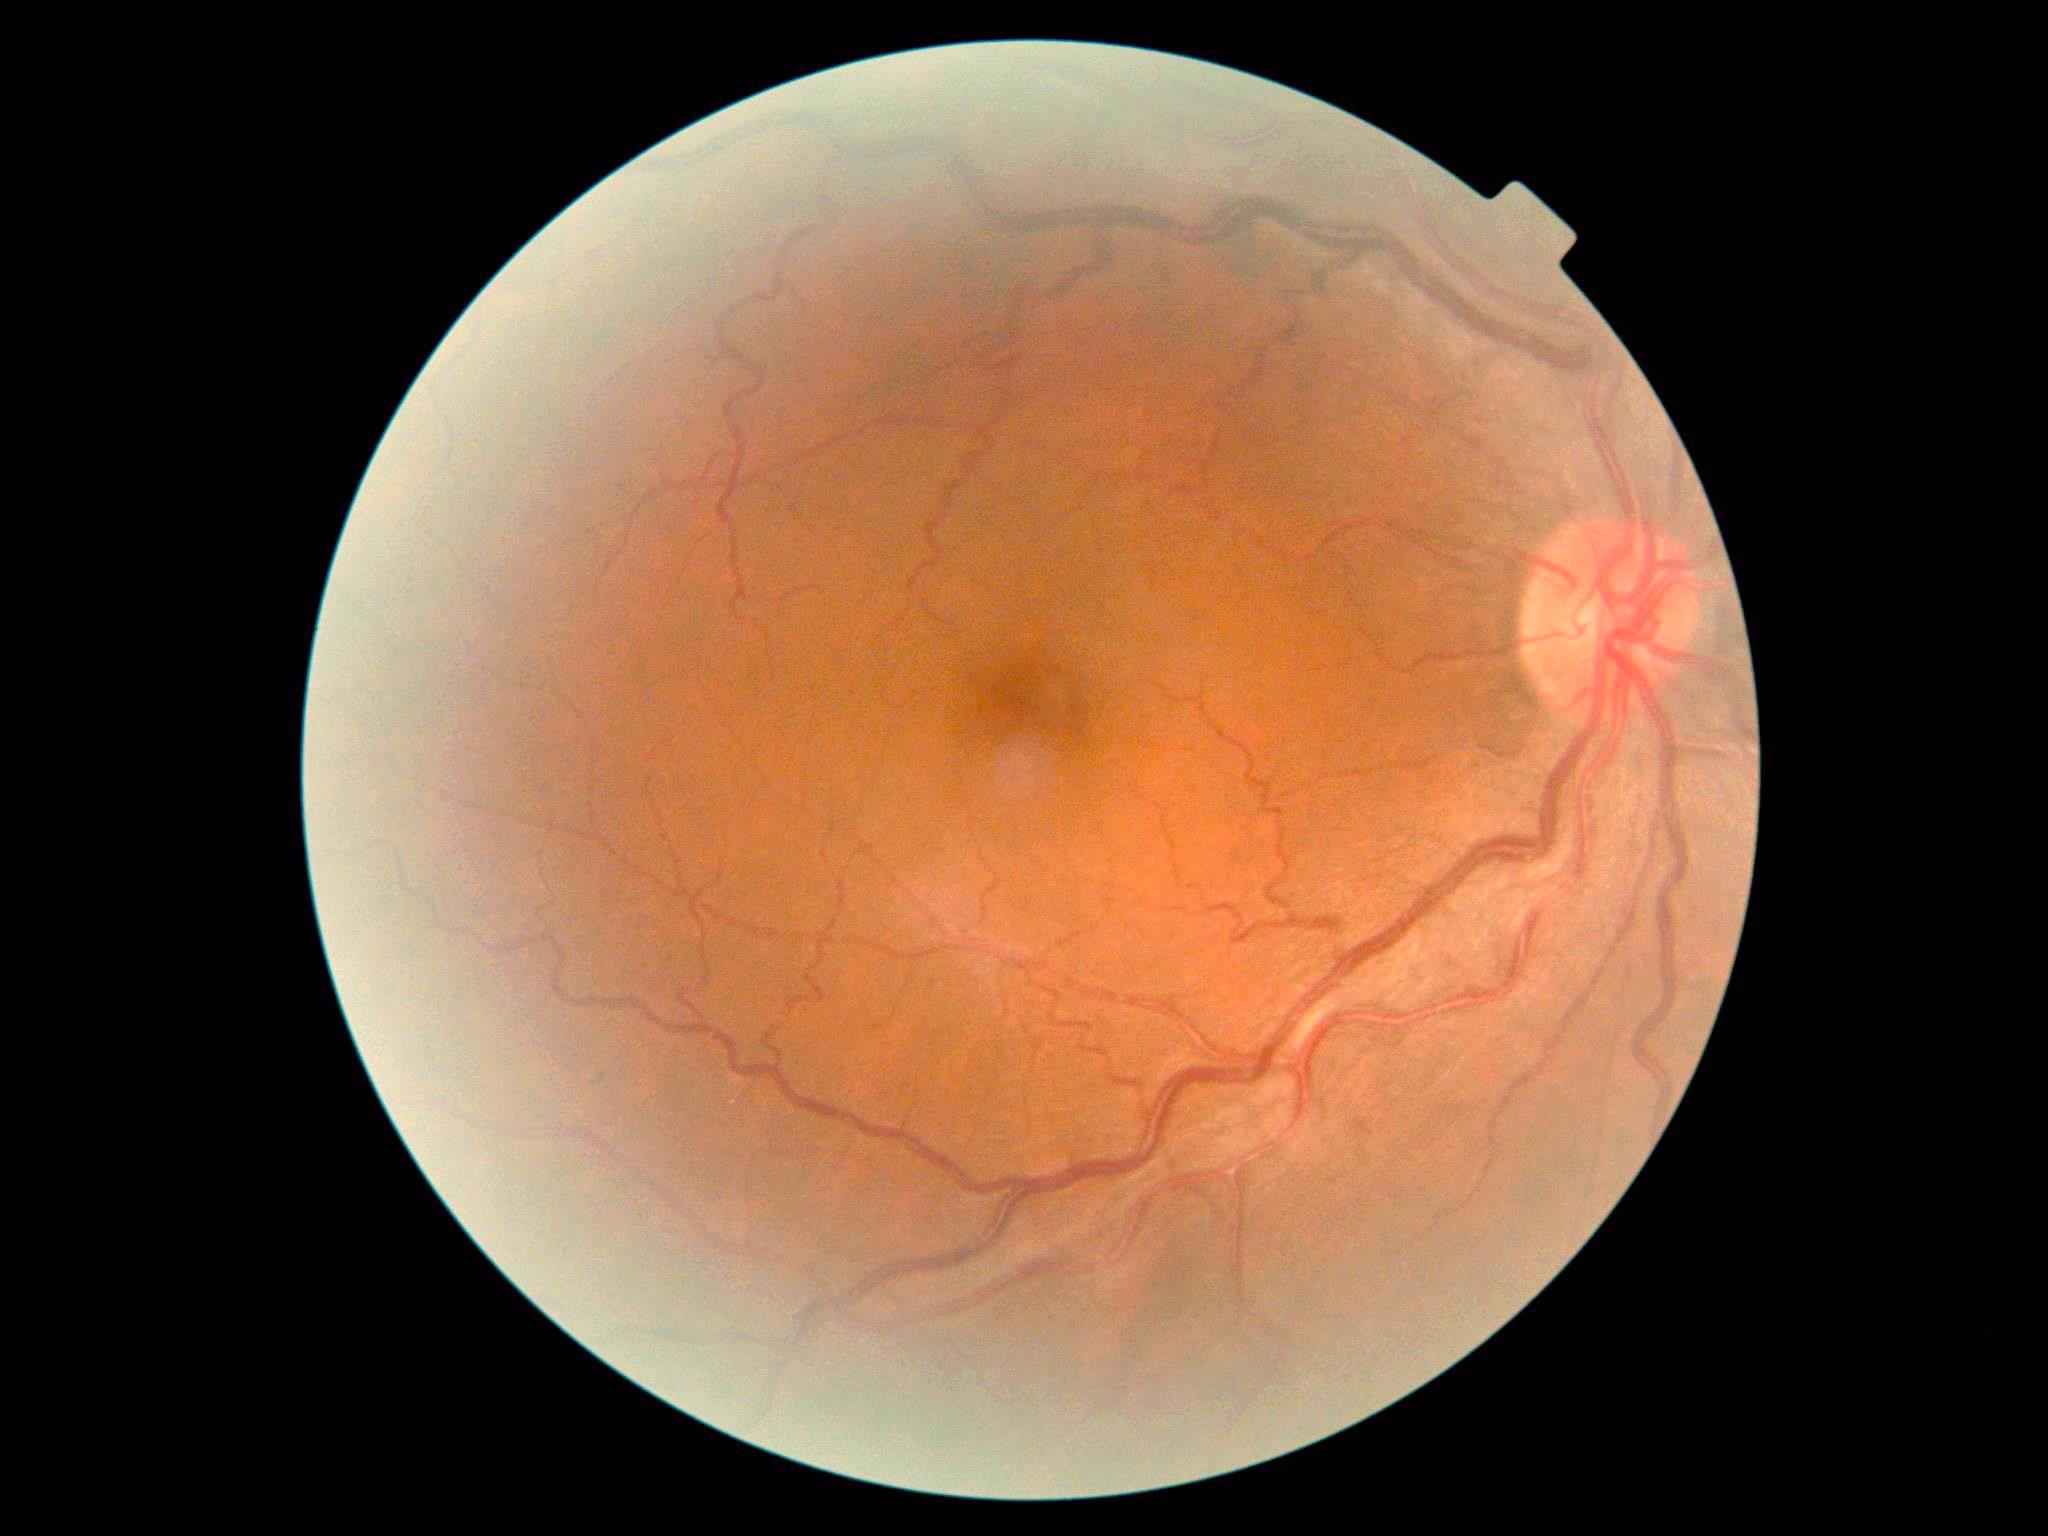 DR severity is moderate non-proliferative diabetic retinopathy (grade 2) — more than just microaneurysms but less than severe NPDR.